NIDEK AFC-230 — 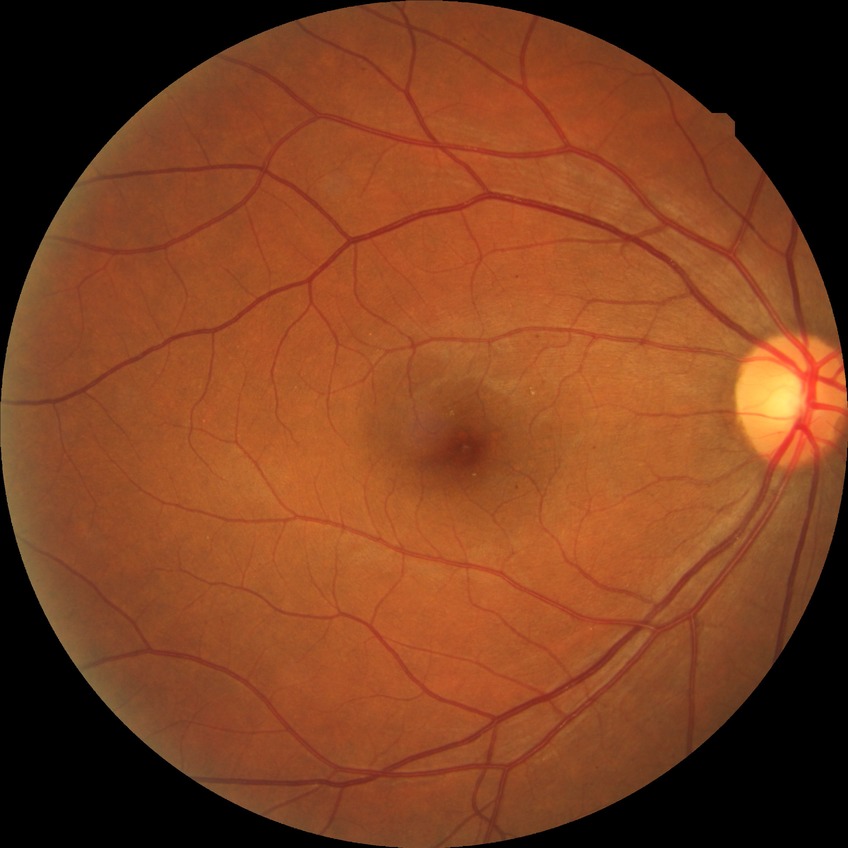

{
  "davis_grade": "SDR"
}